Pediatric wide-field fundus photograph. 1440 by 1080 pixels
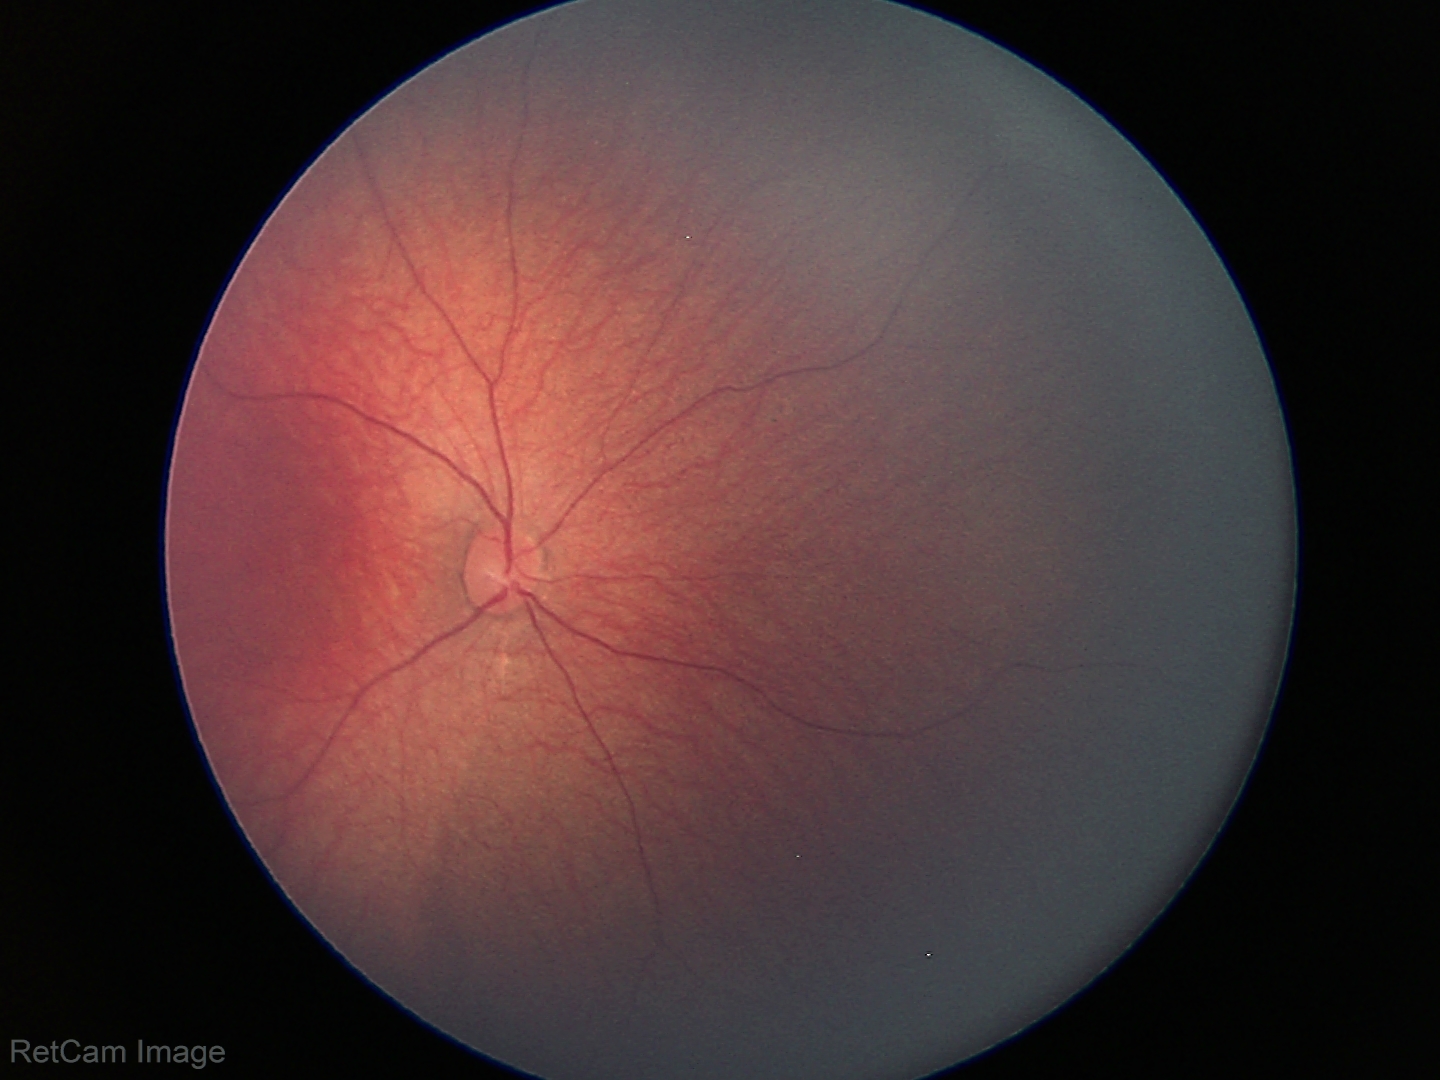
Physiological retinal appearance for postconceptual age.